Infant wide-field retinal image. 640x480px.
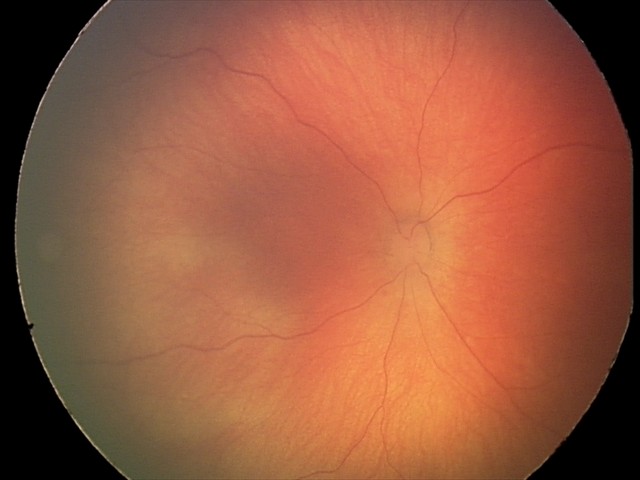

Screening diagnosis = retinal hemorrhages.